Wide-field fundus photograph of an infant.
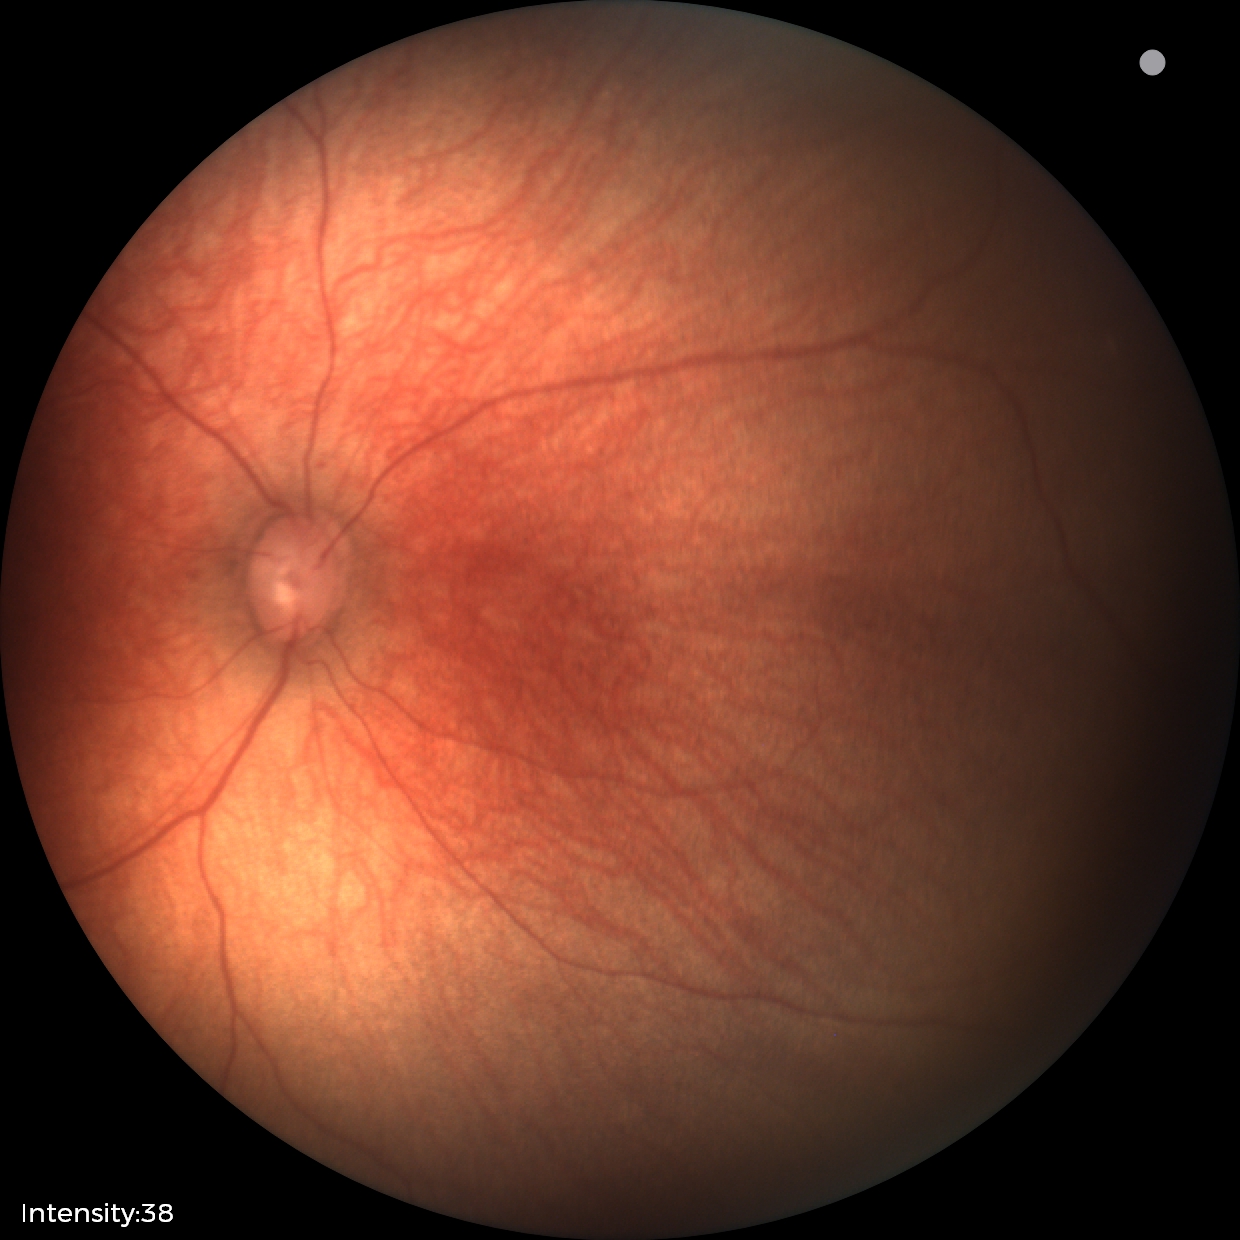

Assessment = physiological